Modified Davis grading — 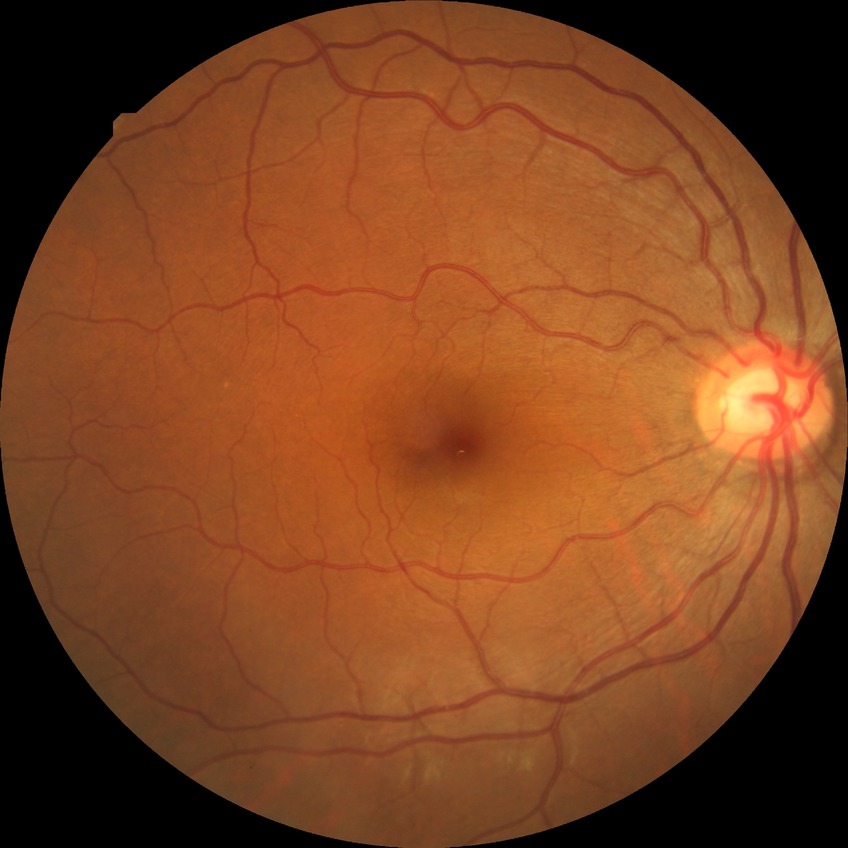

Diabetic retinopathy (DR): NDR (no diabetic retinopathy).